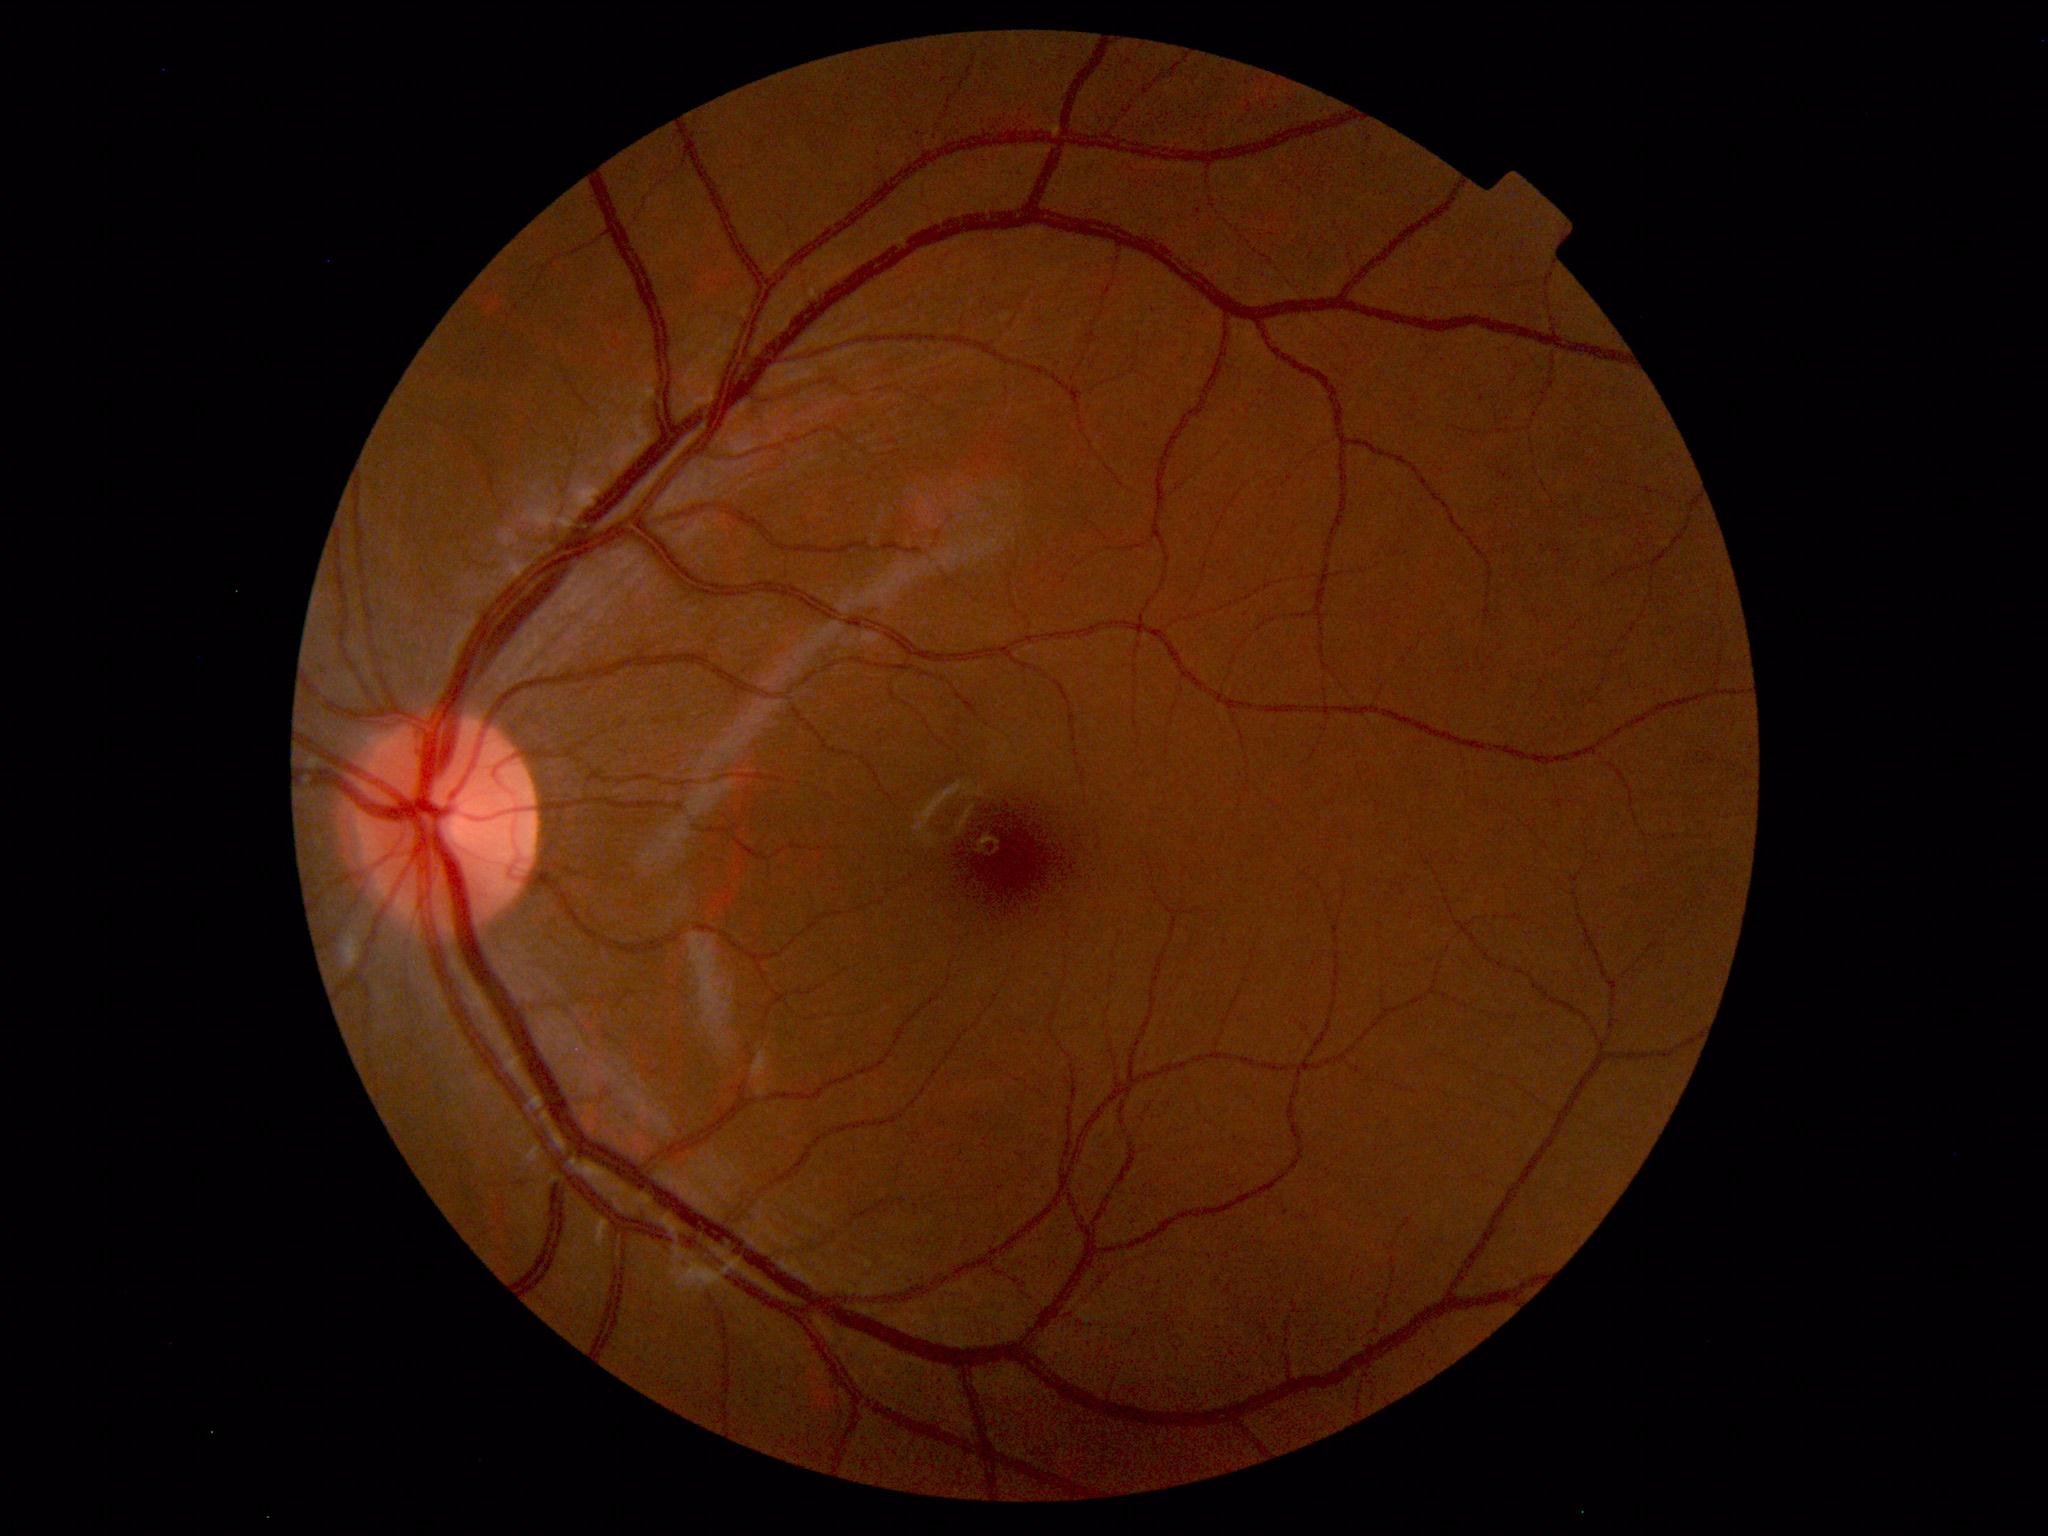
Normal fundus. No pathology identified.